Image size 2089x1764, color fundus photograph
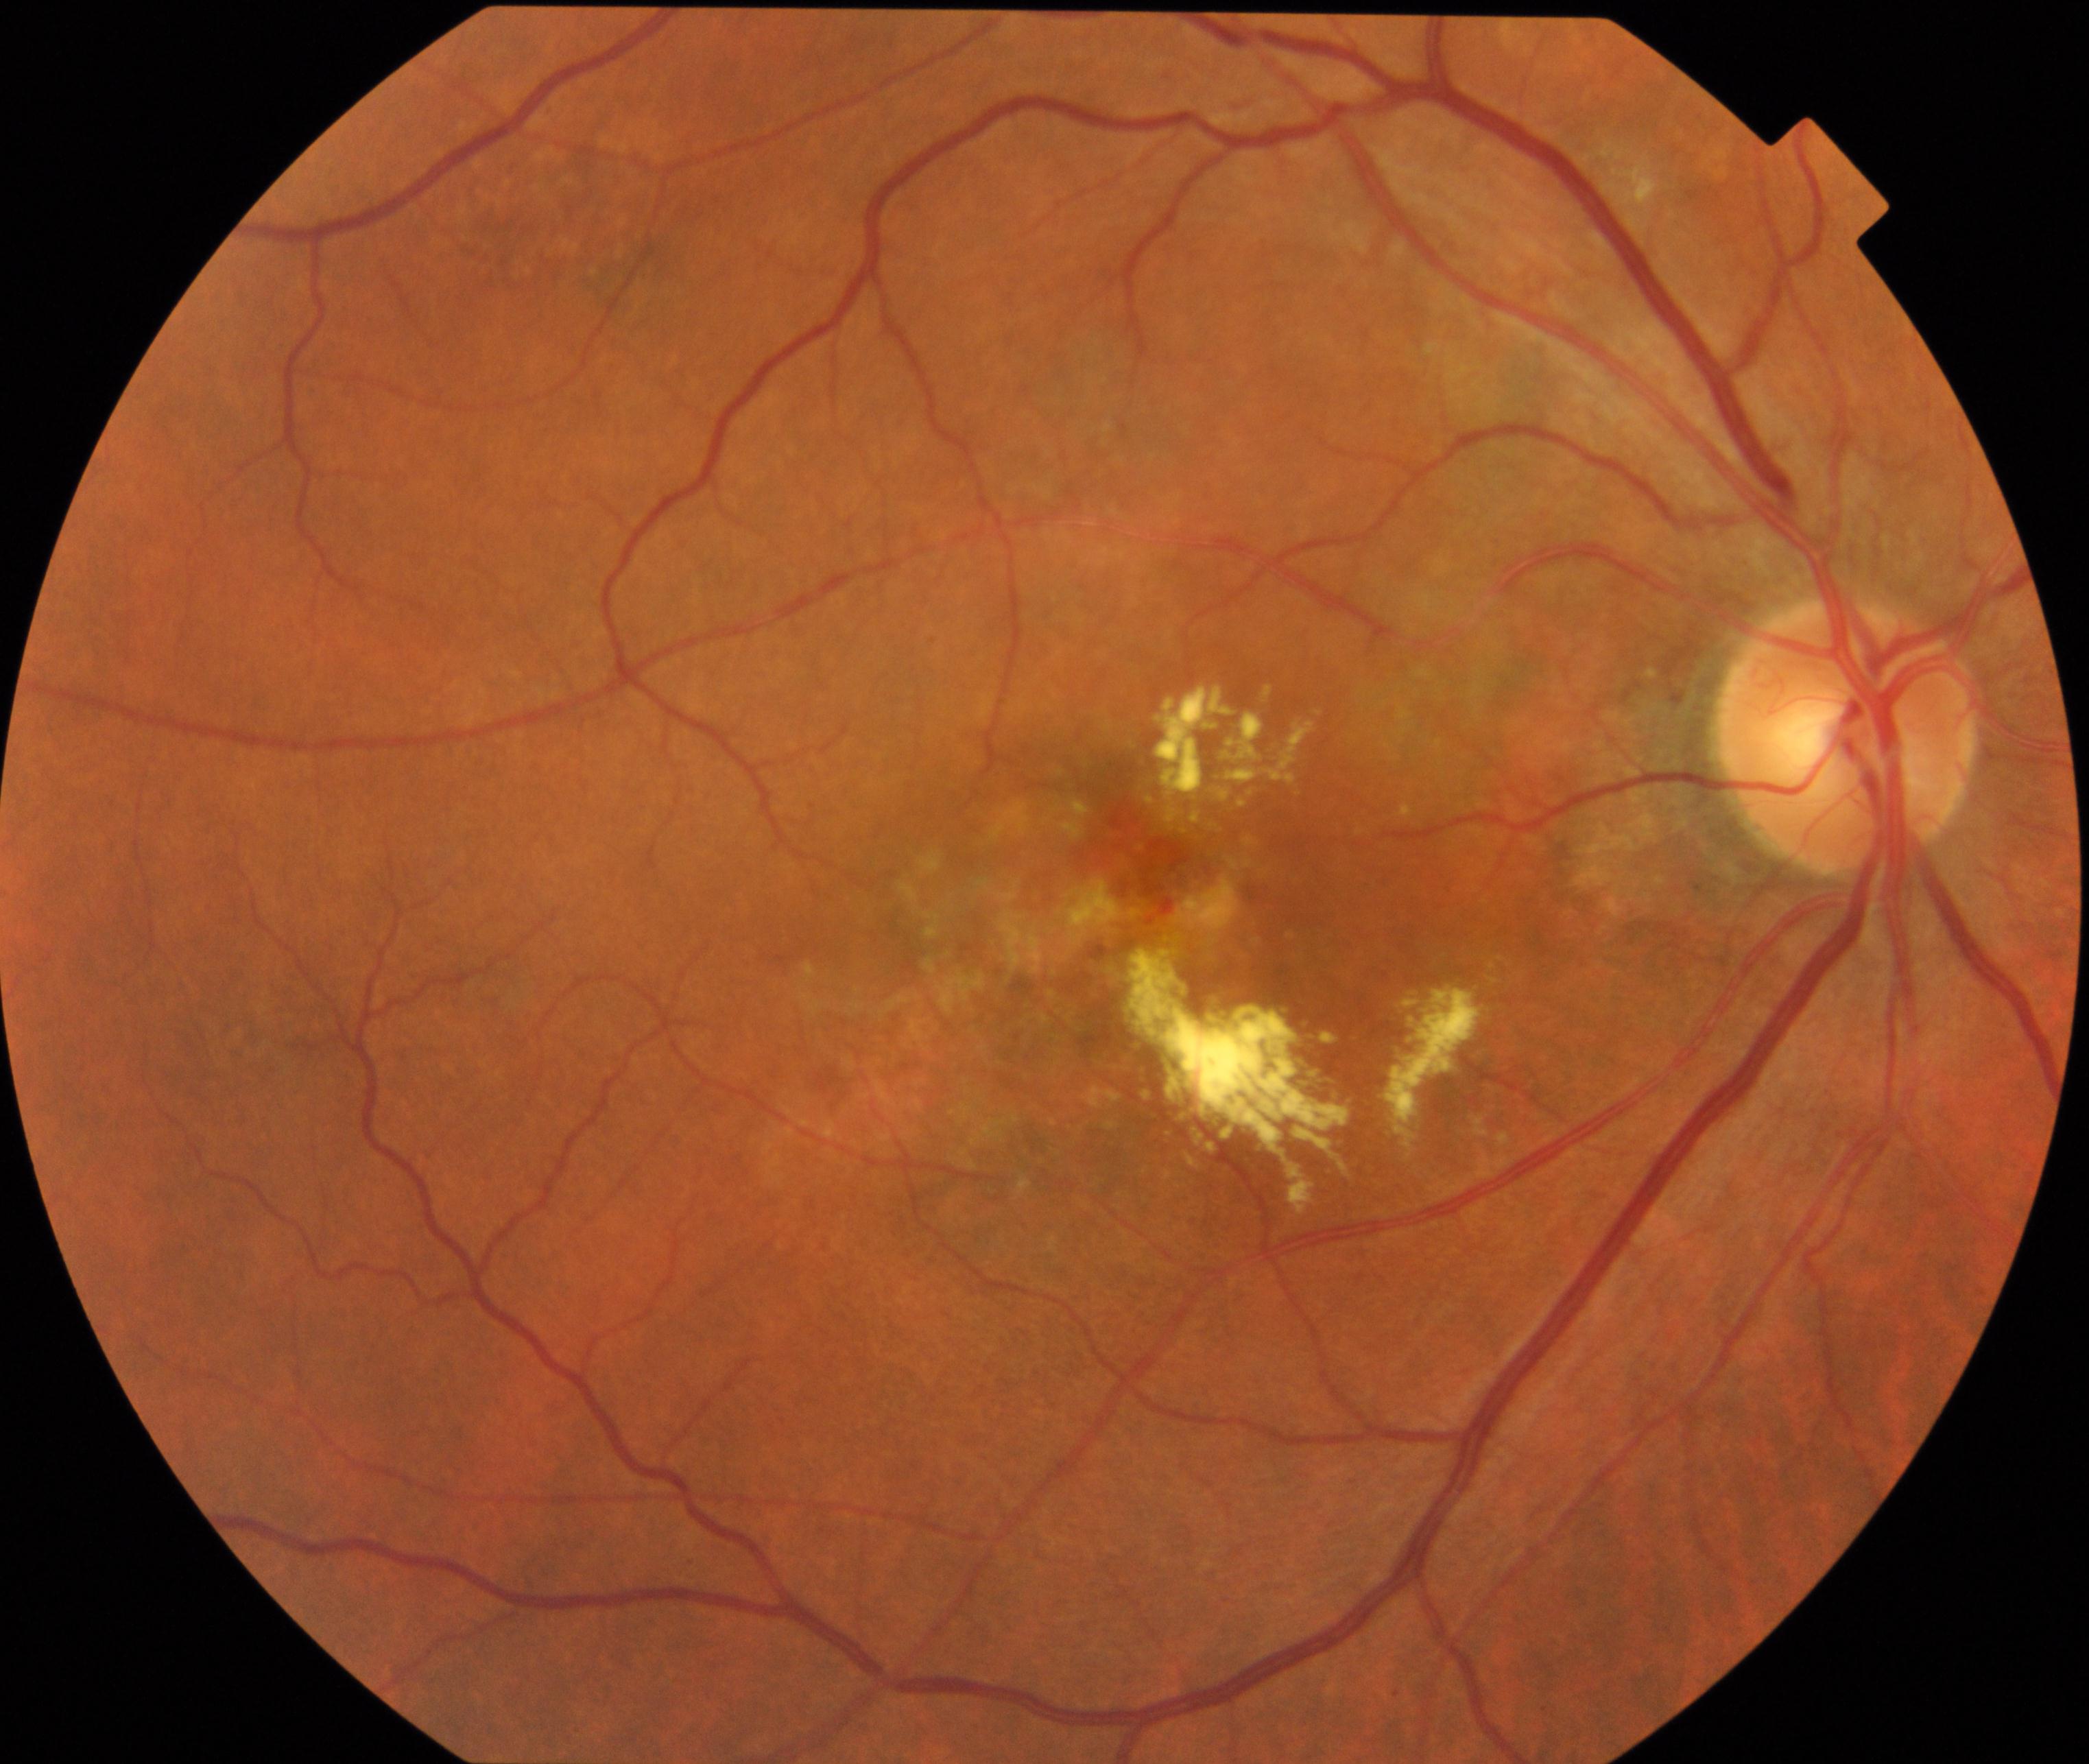

Consistent with maculopathy. Features include lesions within the macular area, such as intermediate or neovascular age-related macular degeneration, retinal angiomatous proliferation, polypoidal choroidal vasculopathy, choroidal neovascularization, idiopathic macular telangiectasia, and macular atrophy, not caused by other listed disease categories.